Graded on the modified Davis scale
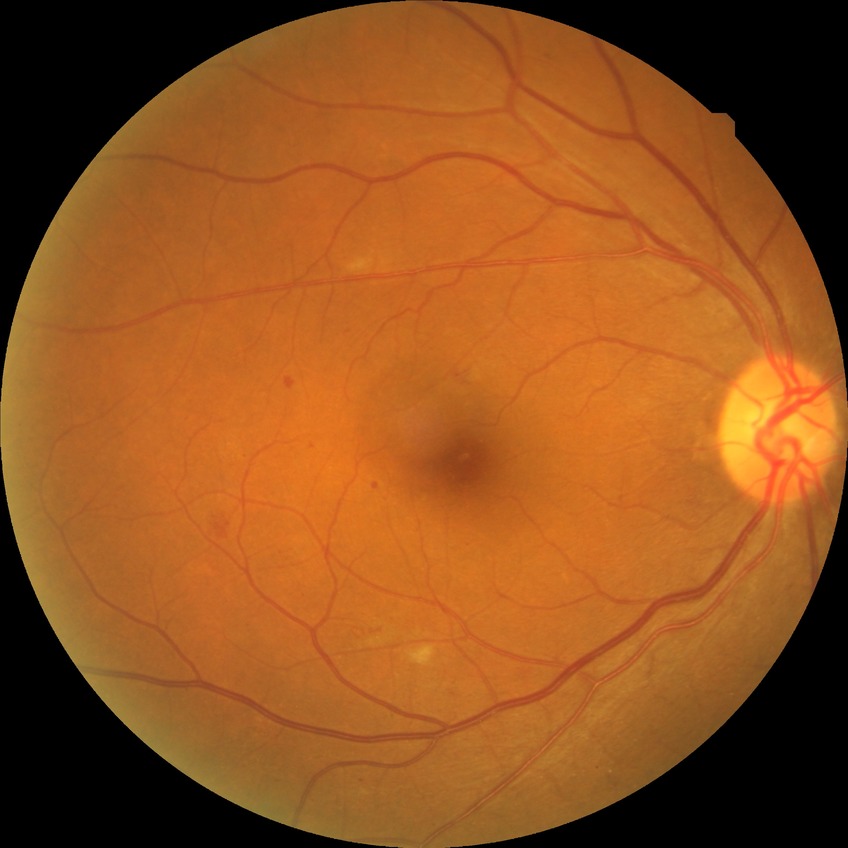

Annotations:
* diabetic retinopathy (DR) — simple diabetic retinopathy (SDR)